Posterior pole color fundus photograph · 848 by 848 pixels:
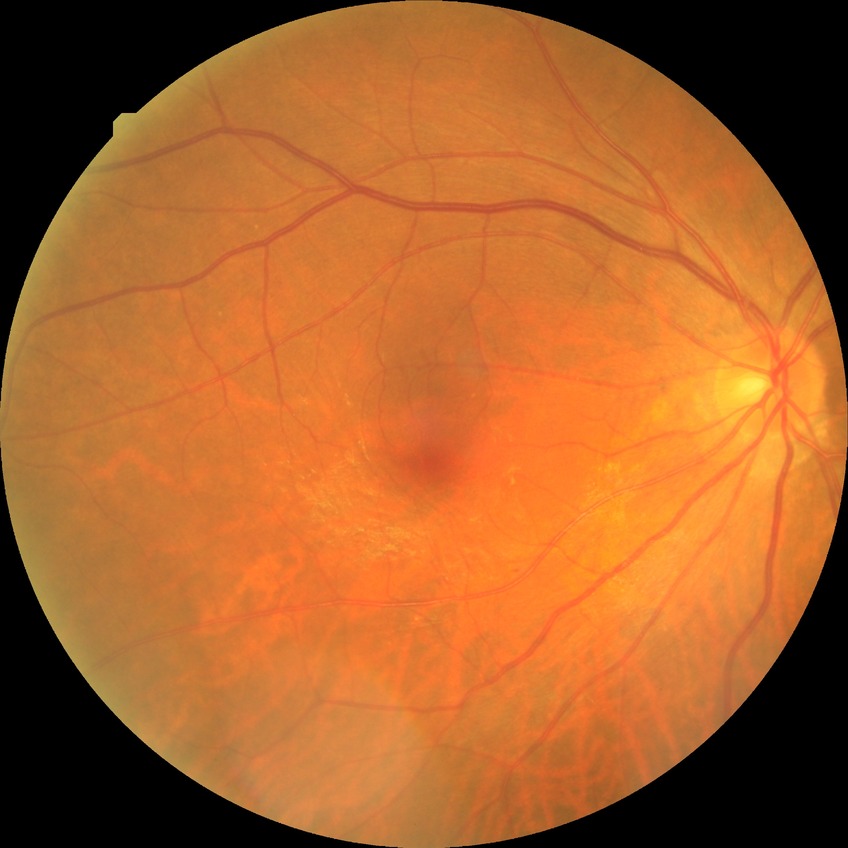
davis_grade: no diabetic retinopathy